Wide-field retinal mosaic image.
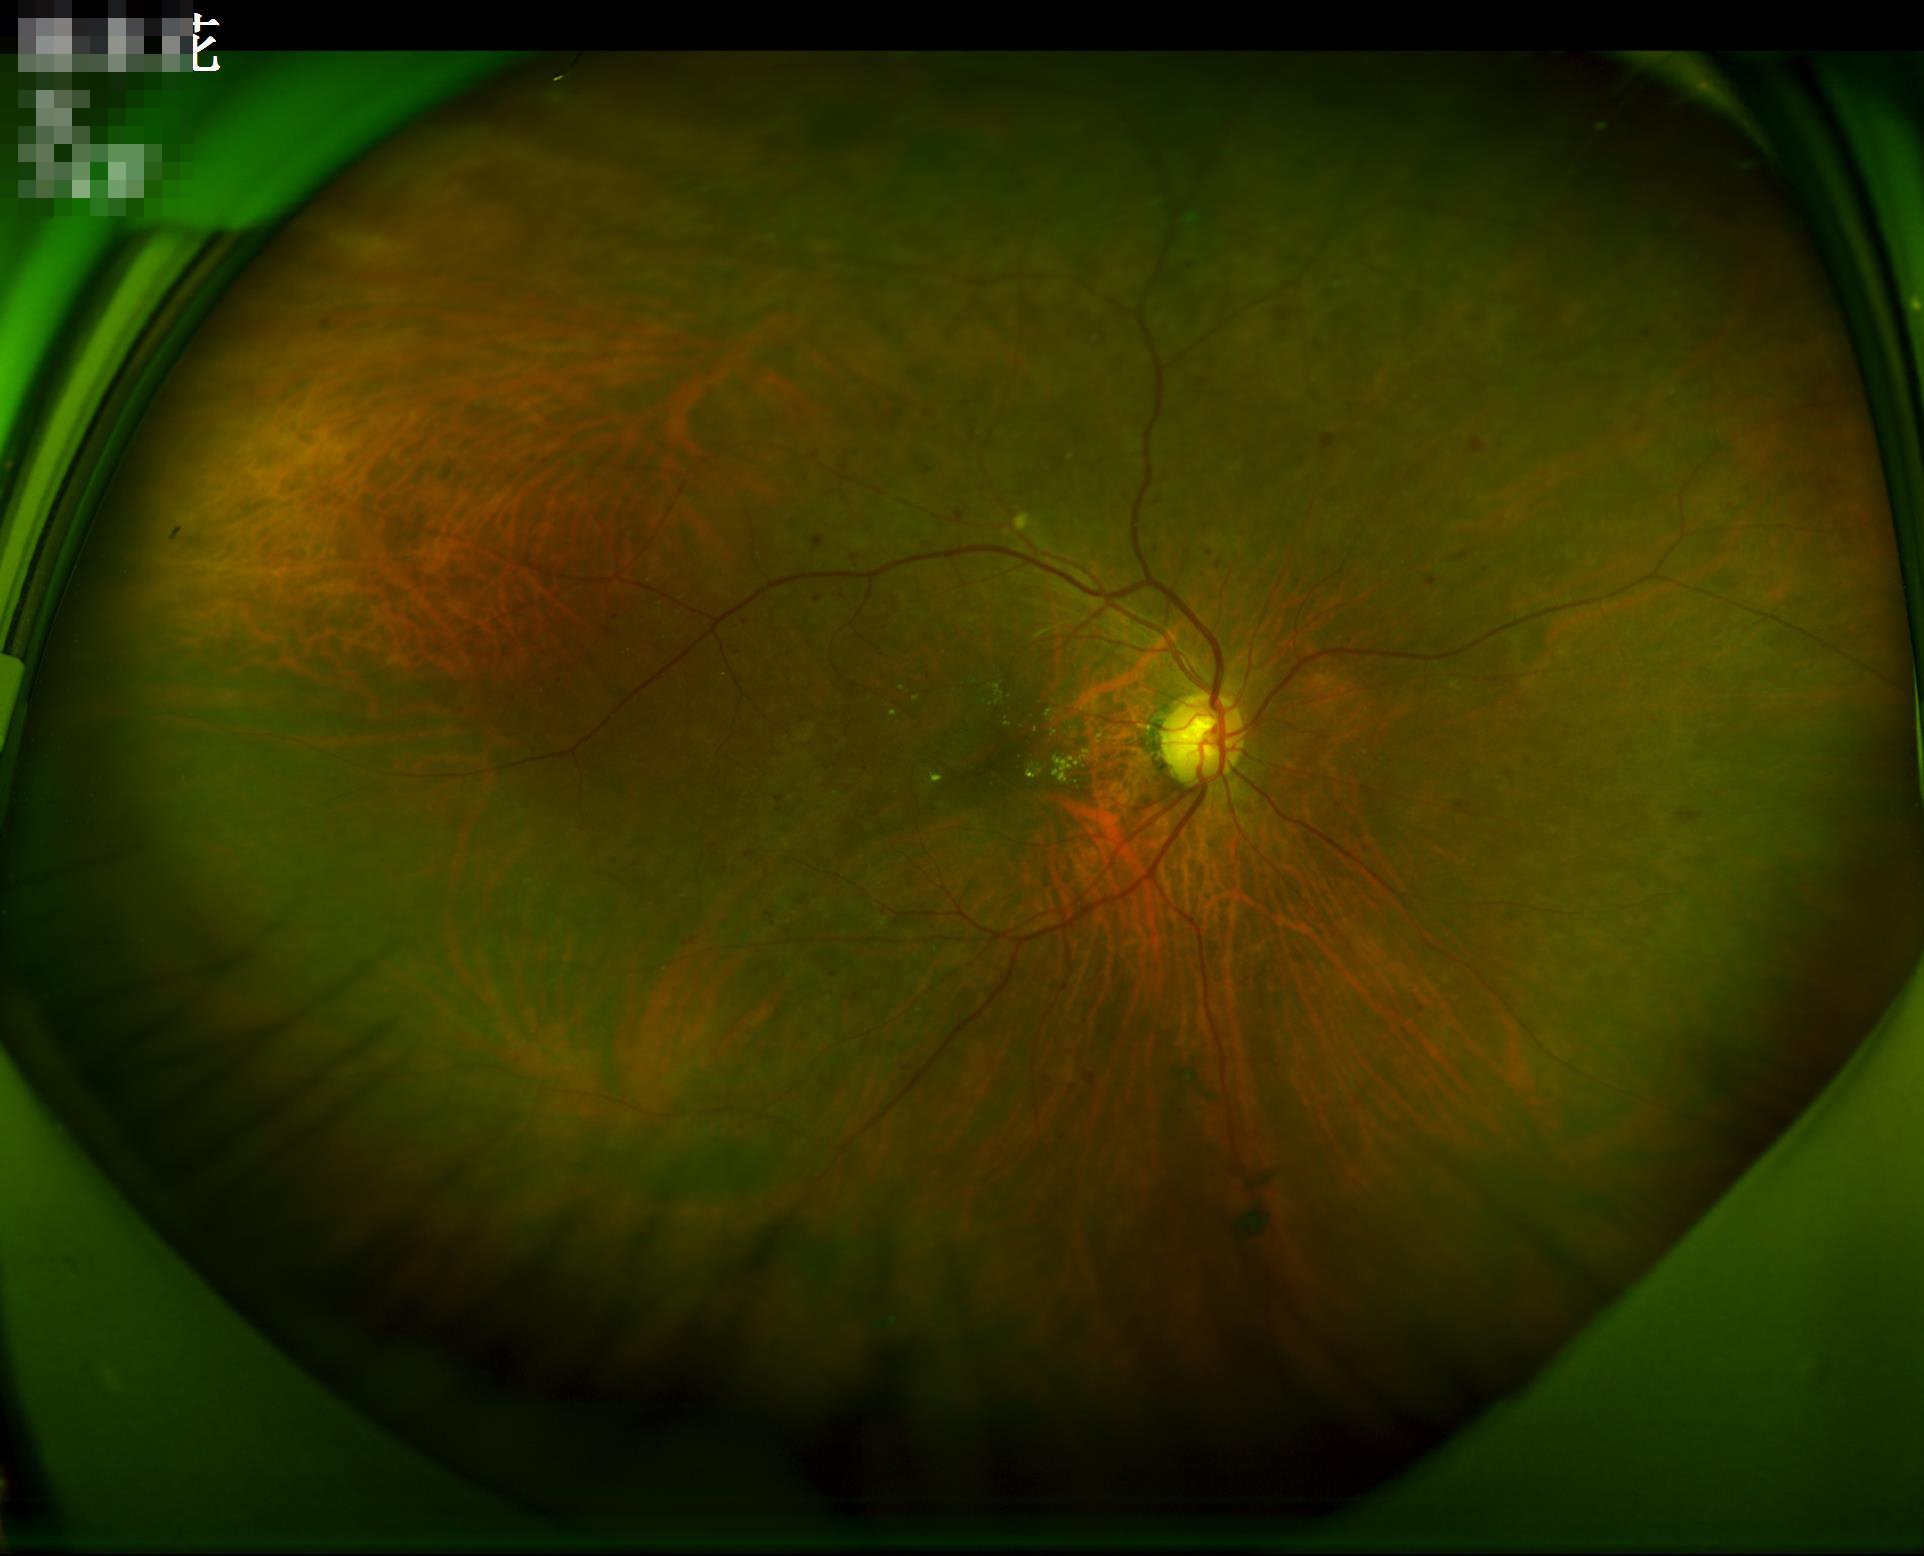
No over- or under-exposure. Image is sharp throughout the field. Acceptable image quality. Adequate contrast for distinguishing structures.